848 by 848 pixels; nonmydriatic fundus photograph — 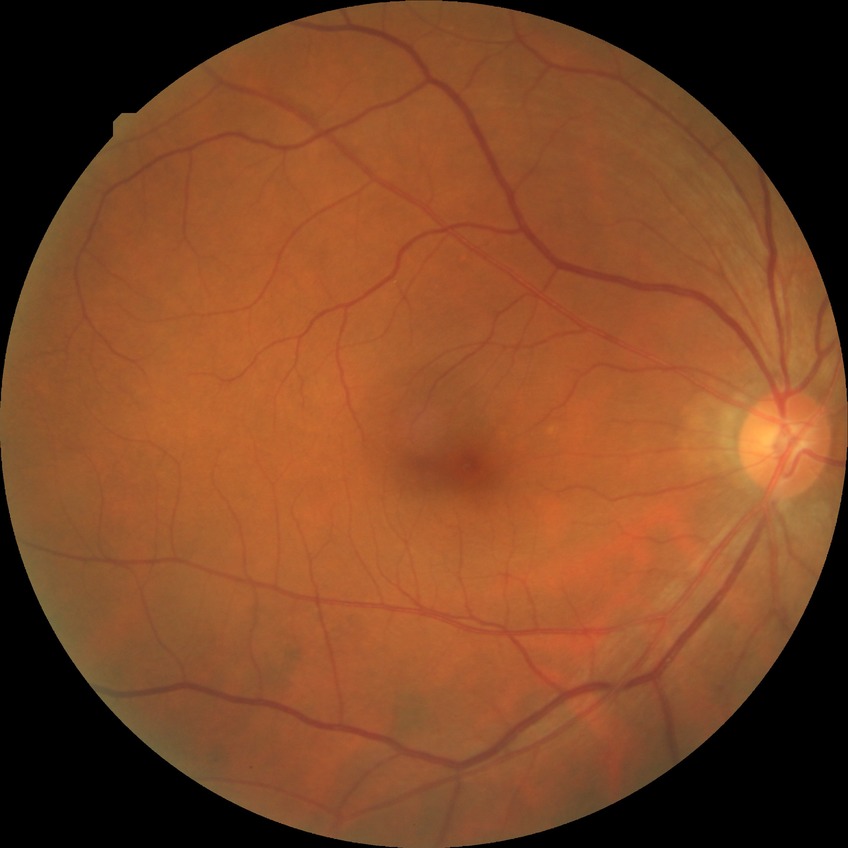
DR stage: NDR.